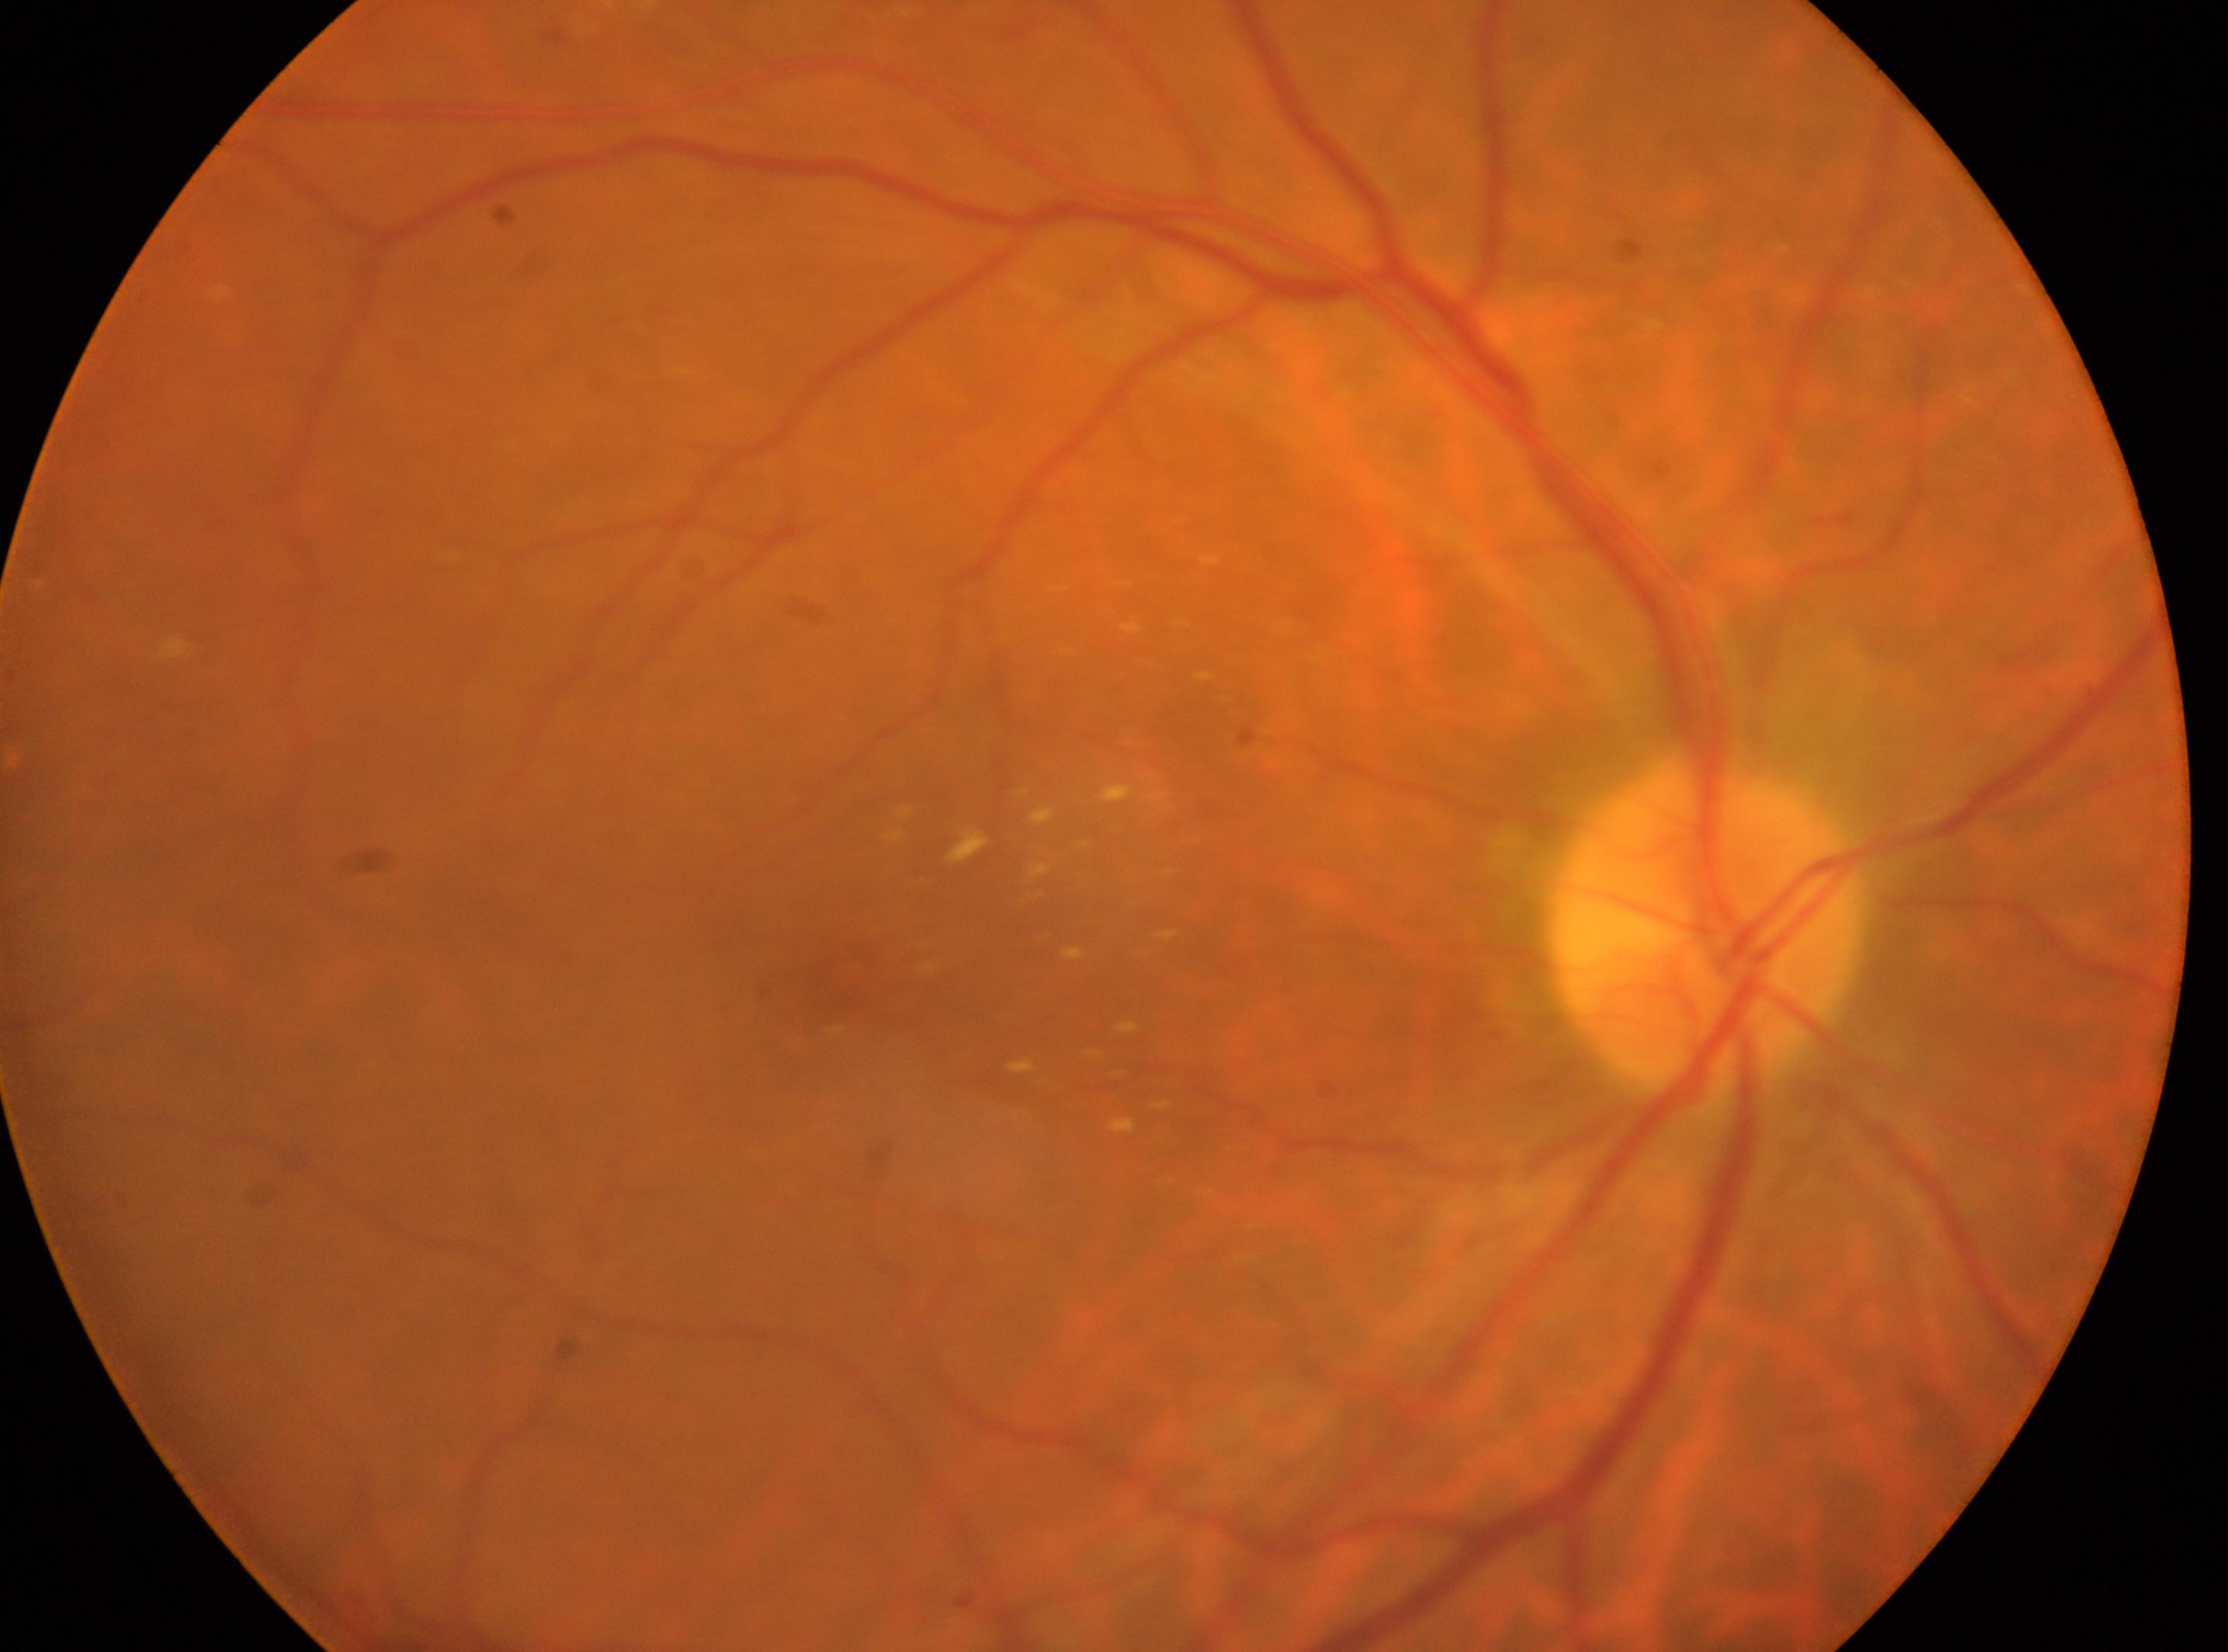 Optic nerve head located at 1703, 927. The fovea is at 839, 984. This is the right eye. Diabetic retinopathy grade is 2/4.